Camera: NIDEK AFC-230, graded on the modified Davis scale: 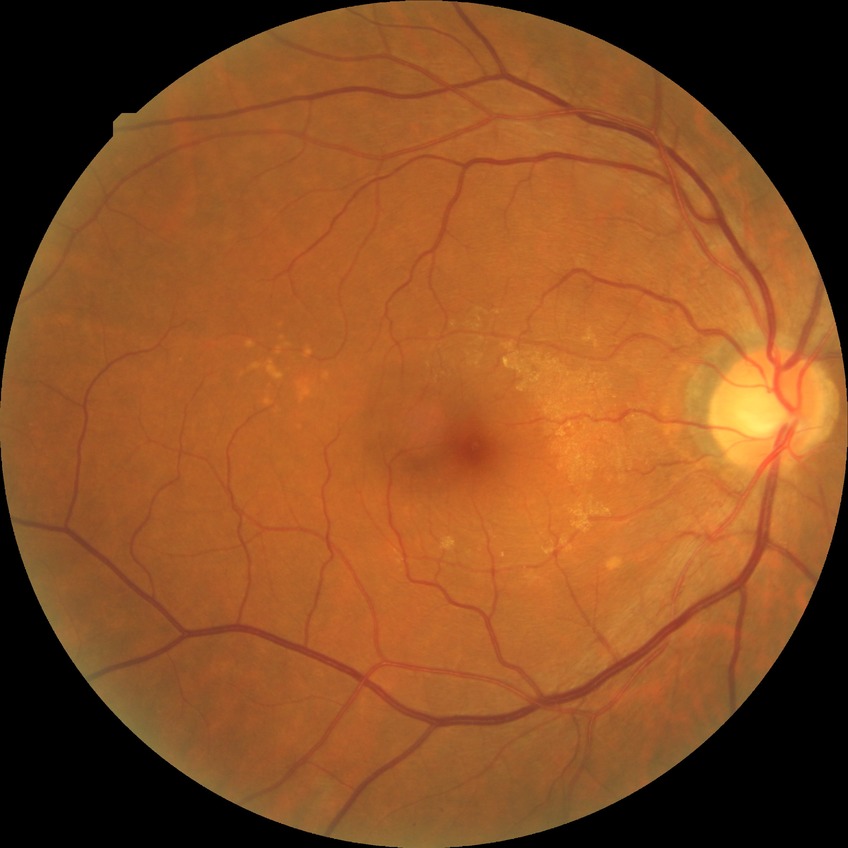

davis_grade: SDR
proliferative_class: non-proliferative diabetic retinopathy